Wide-field fundus photograph of an infant: 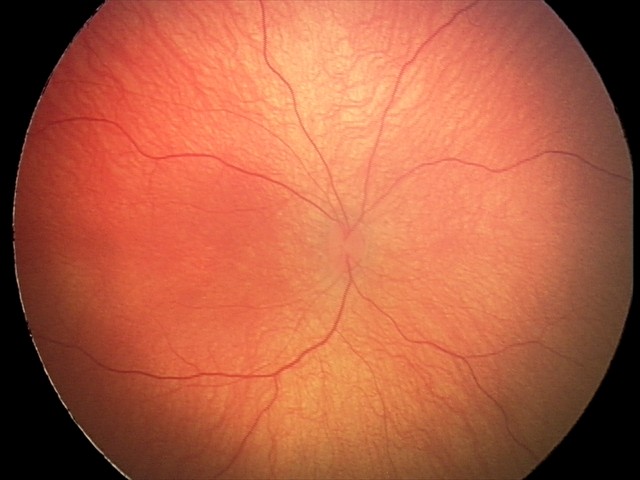
Screening examination with no abnormal retinal findings.